CFP · 512x512px — 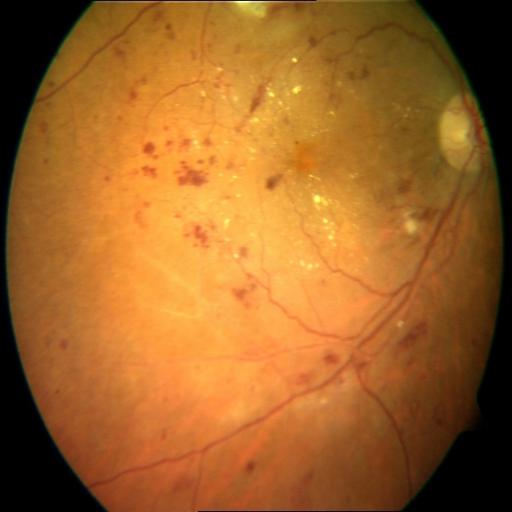

Three findings. Demonstrates media haze, hemorrhagic retinopathy, and exudation.